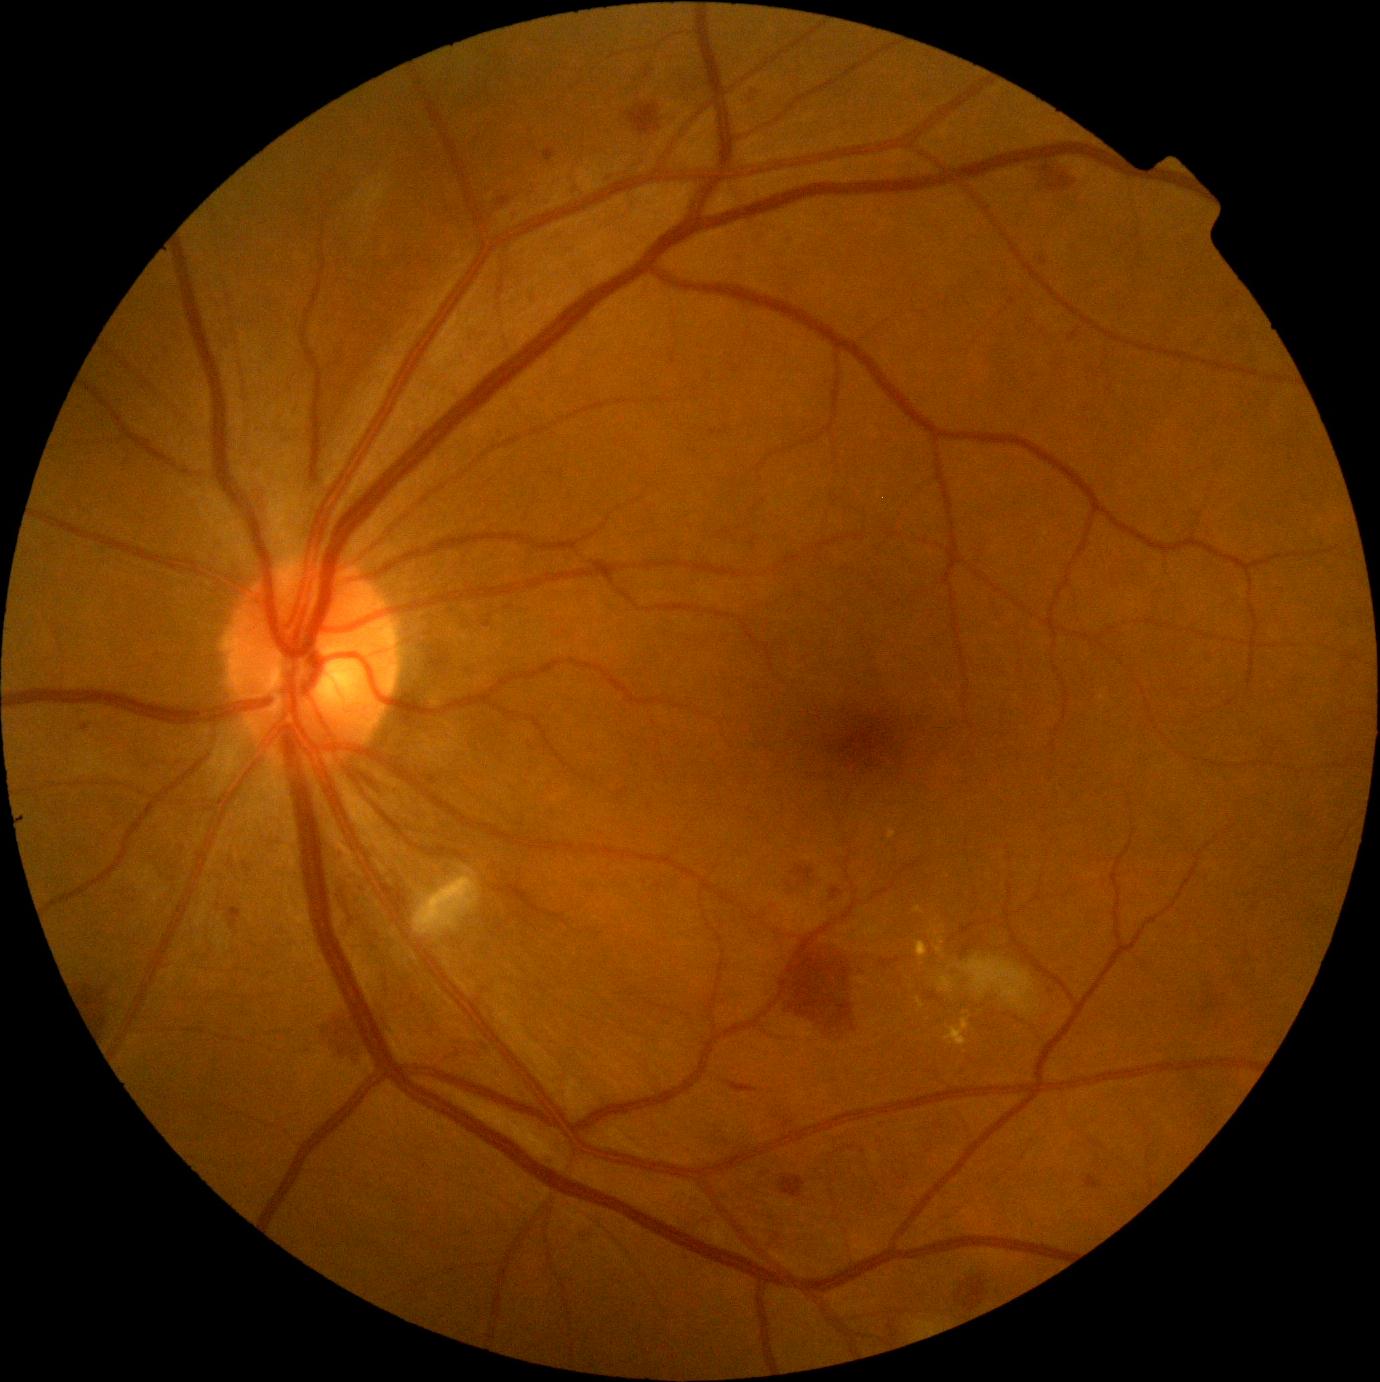

diabetic retinopathy (DR): 2.